Color fundus image.
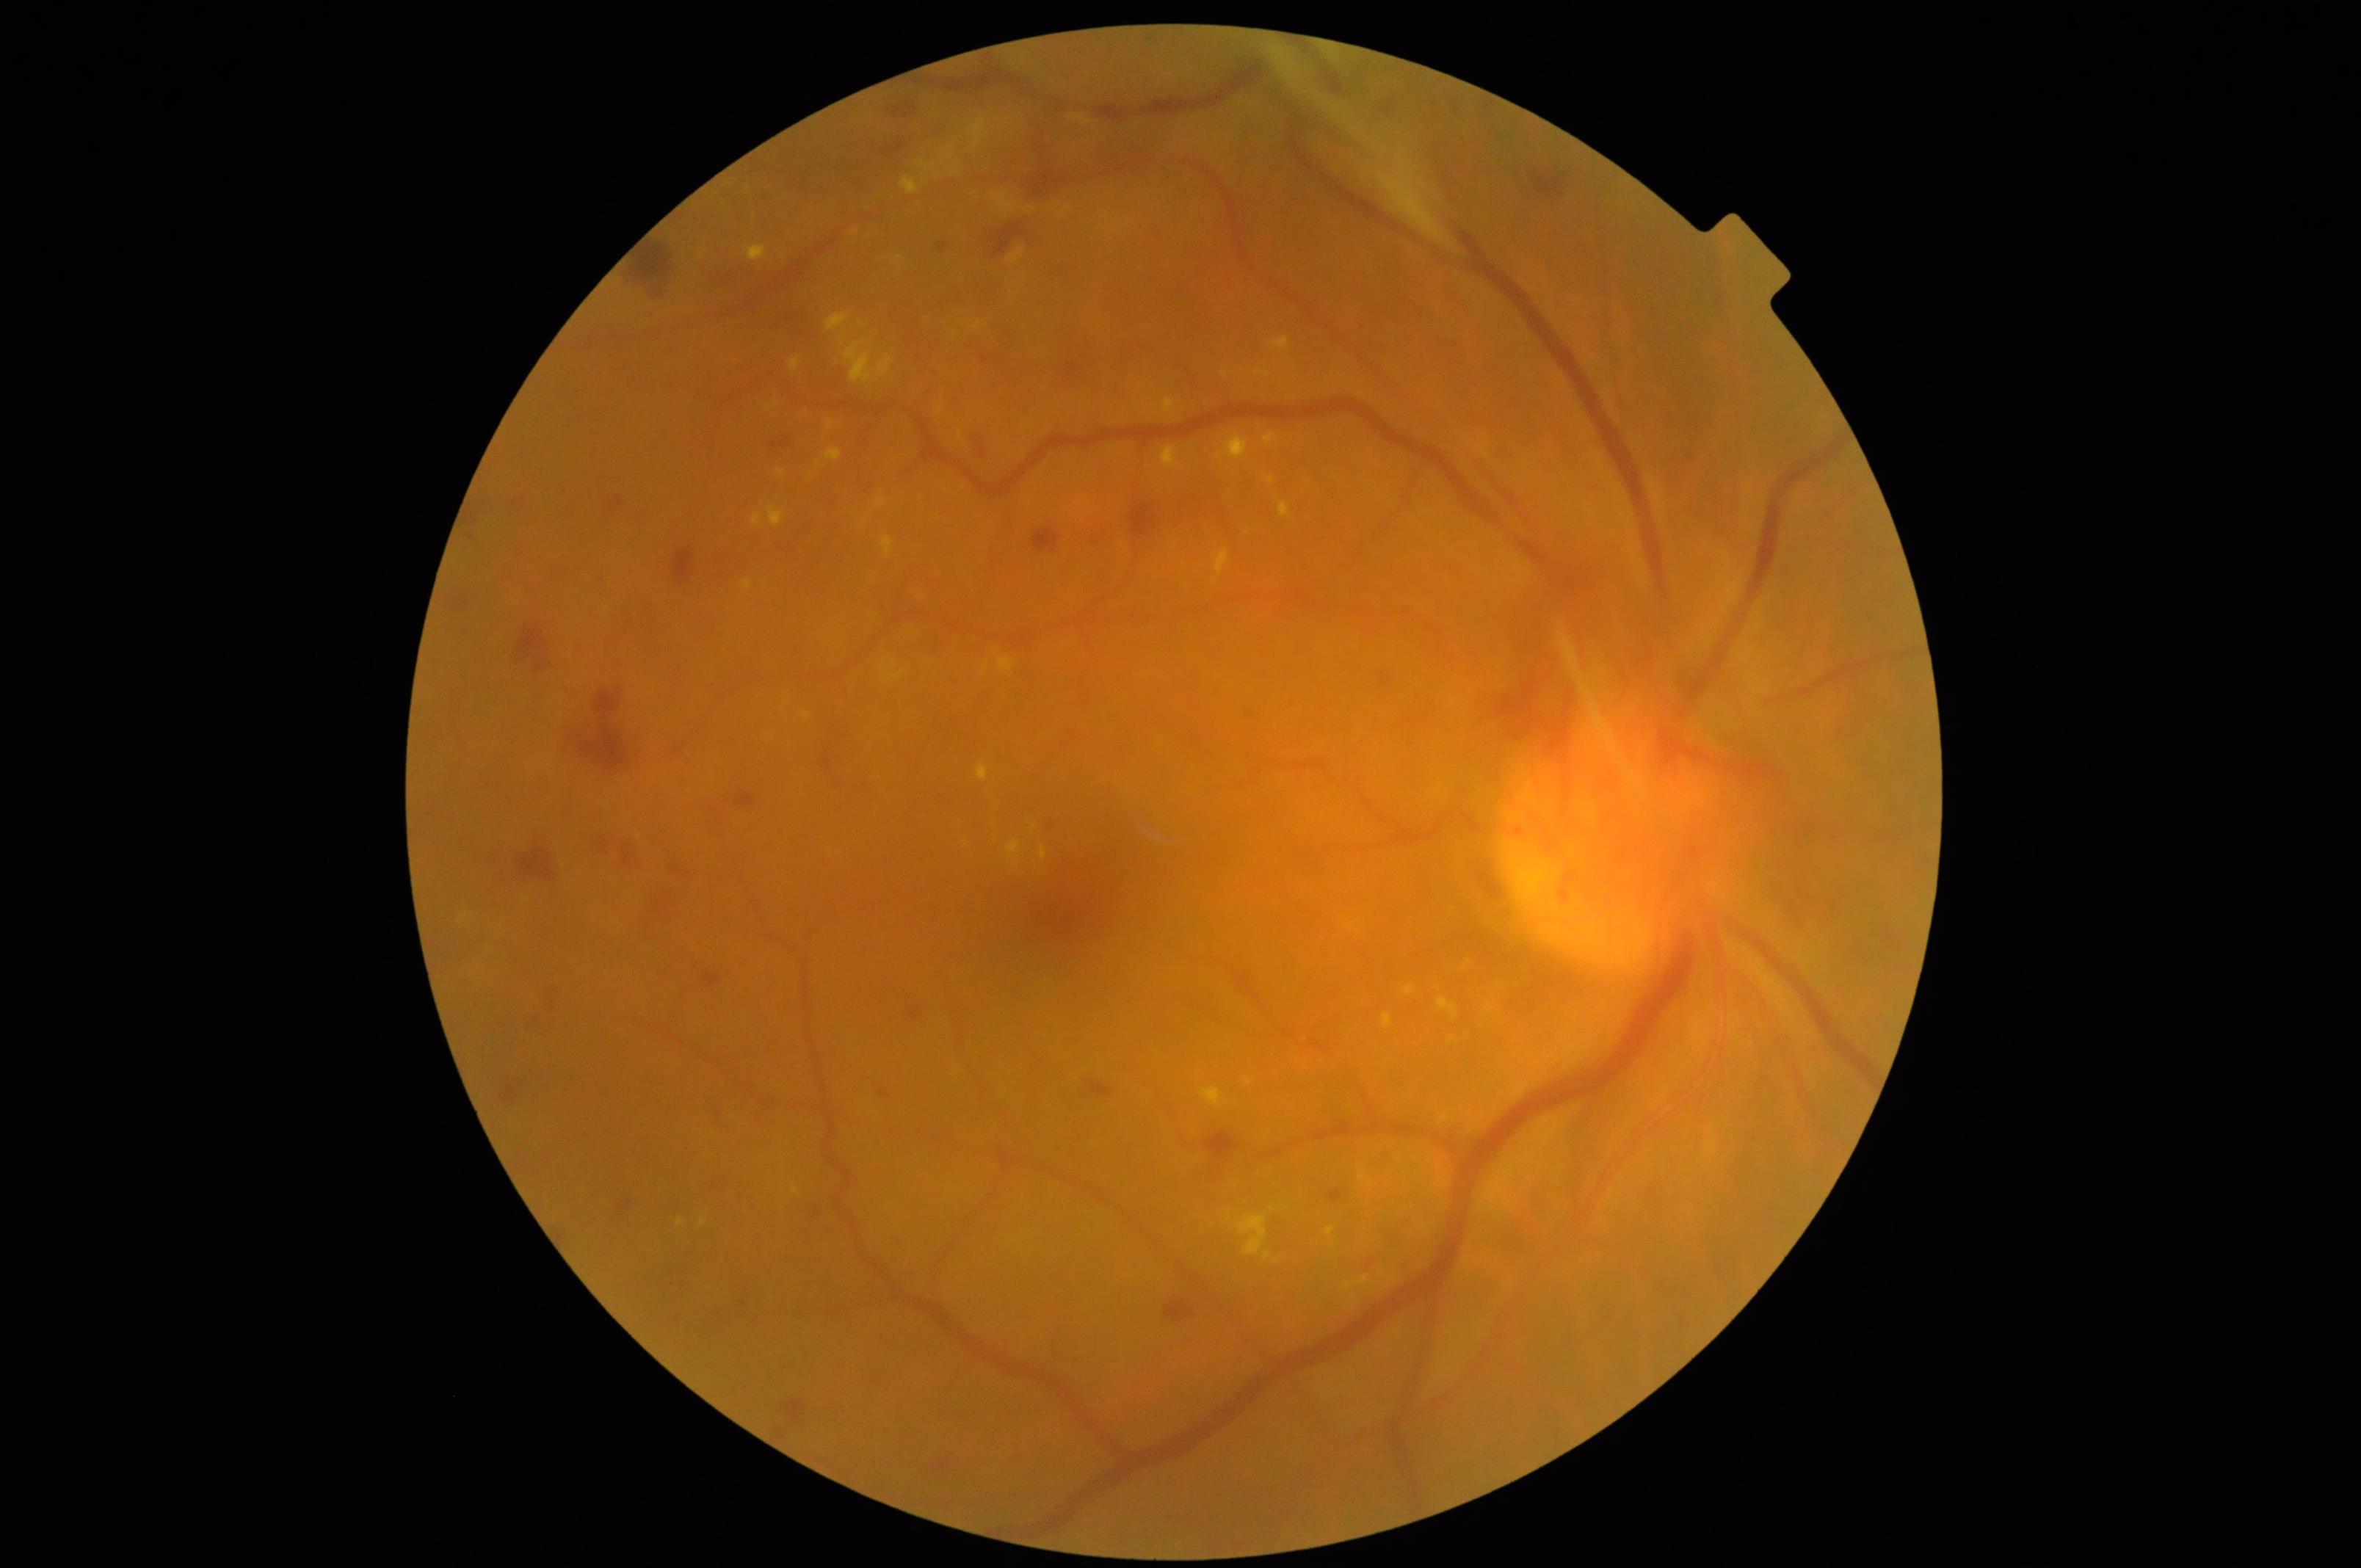 Contrast is good. Overall image quality is good. Reduced sharpness with visible blur.